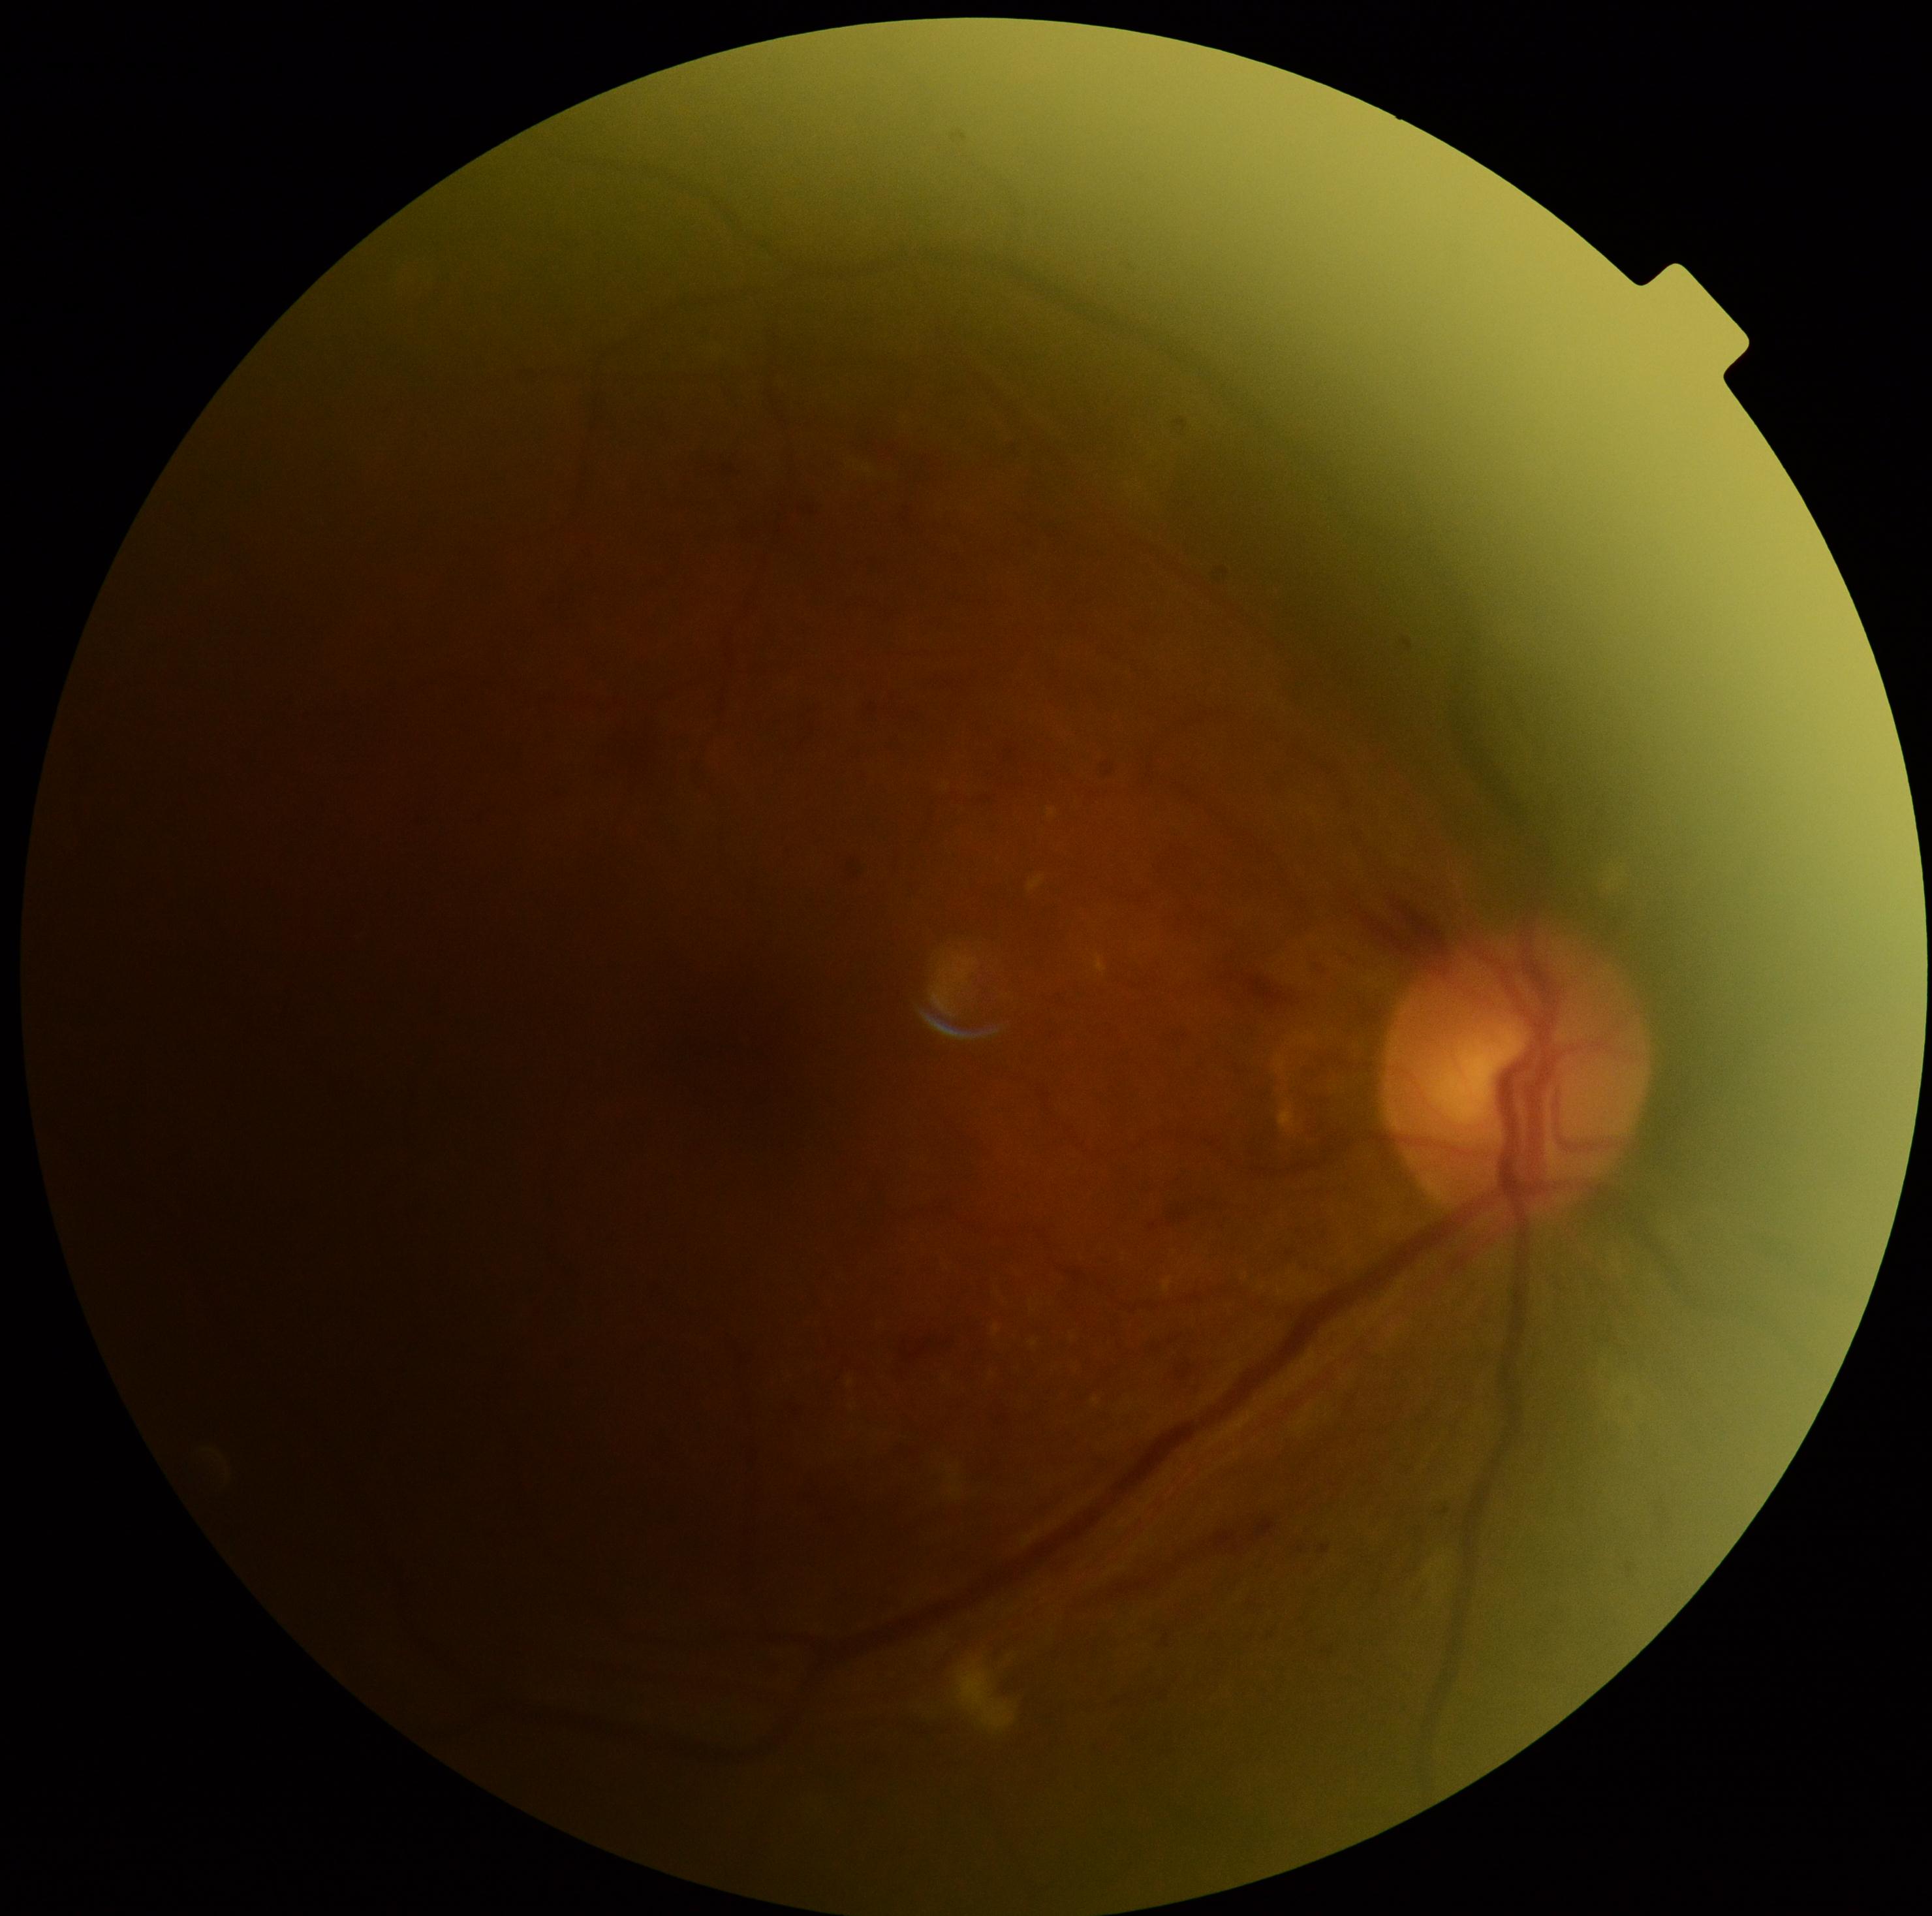

Annotations:
• retinopathy — 2/4
• DR class — non-proliferative diabetic retinopathy